FOV: 45 degrees.
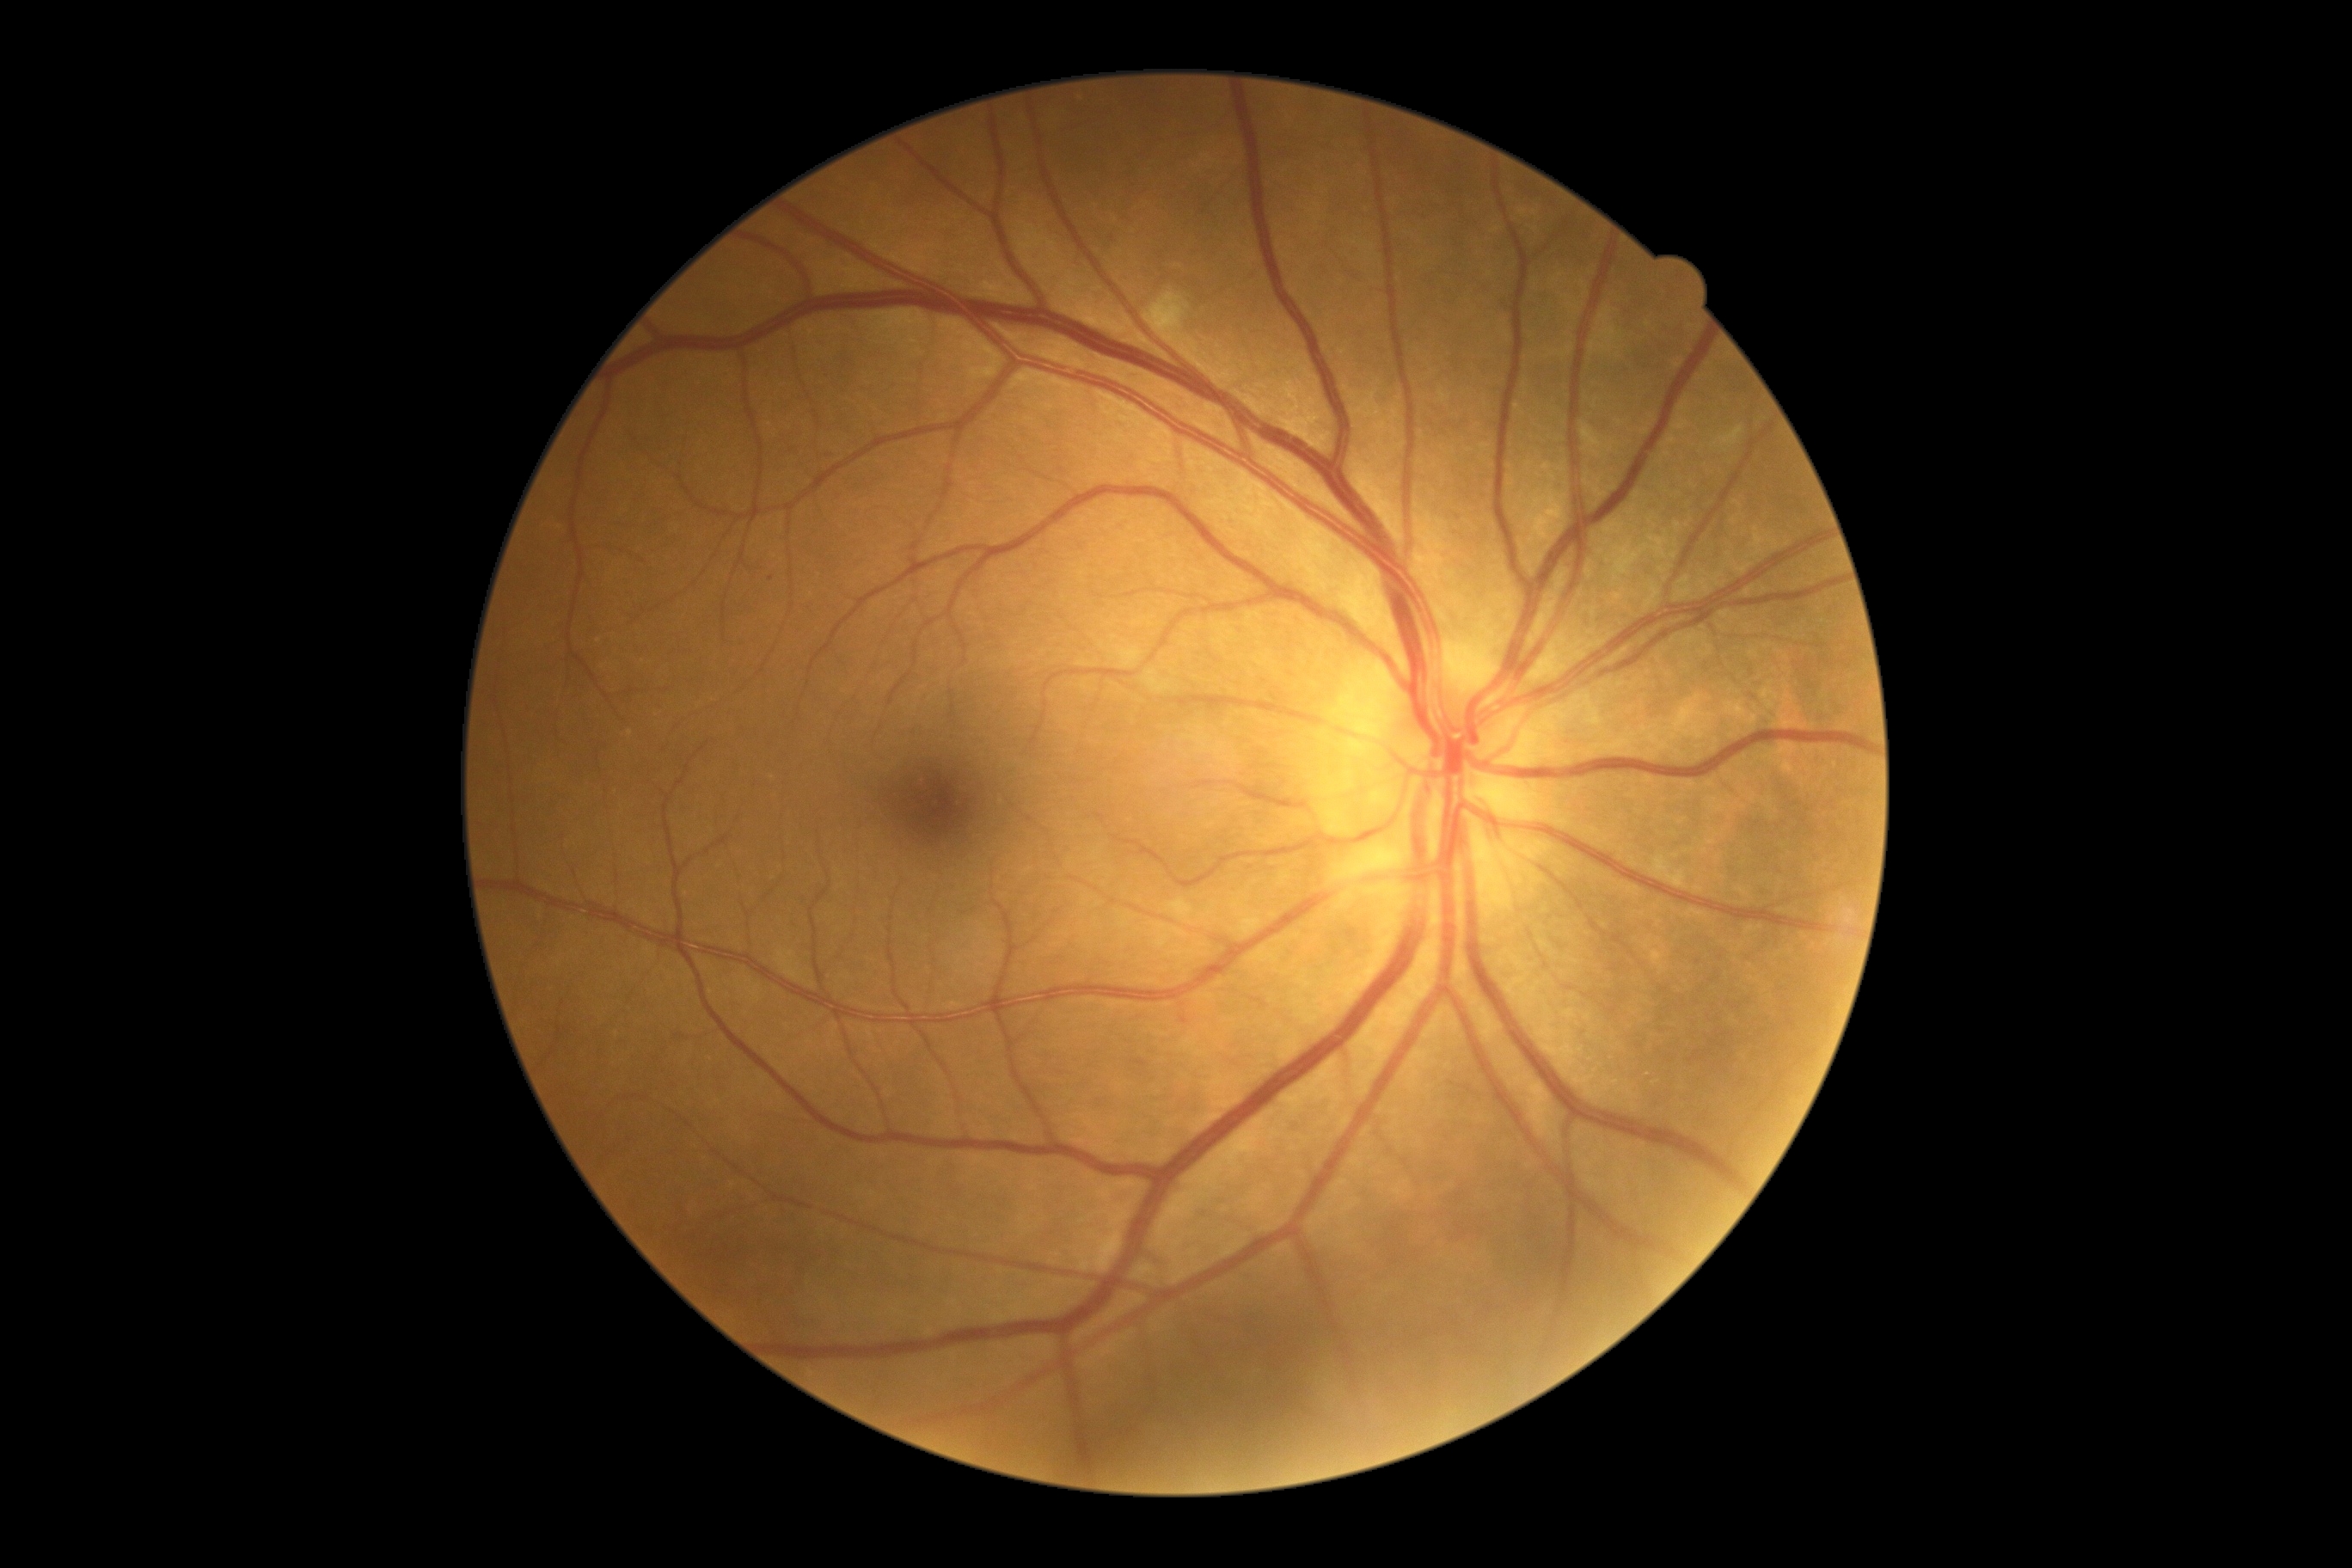
DR grade: 2.